45-degree field of view: 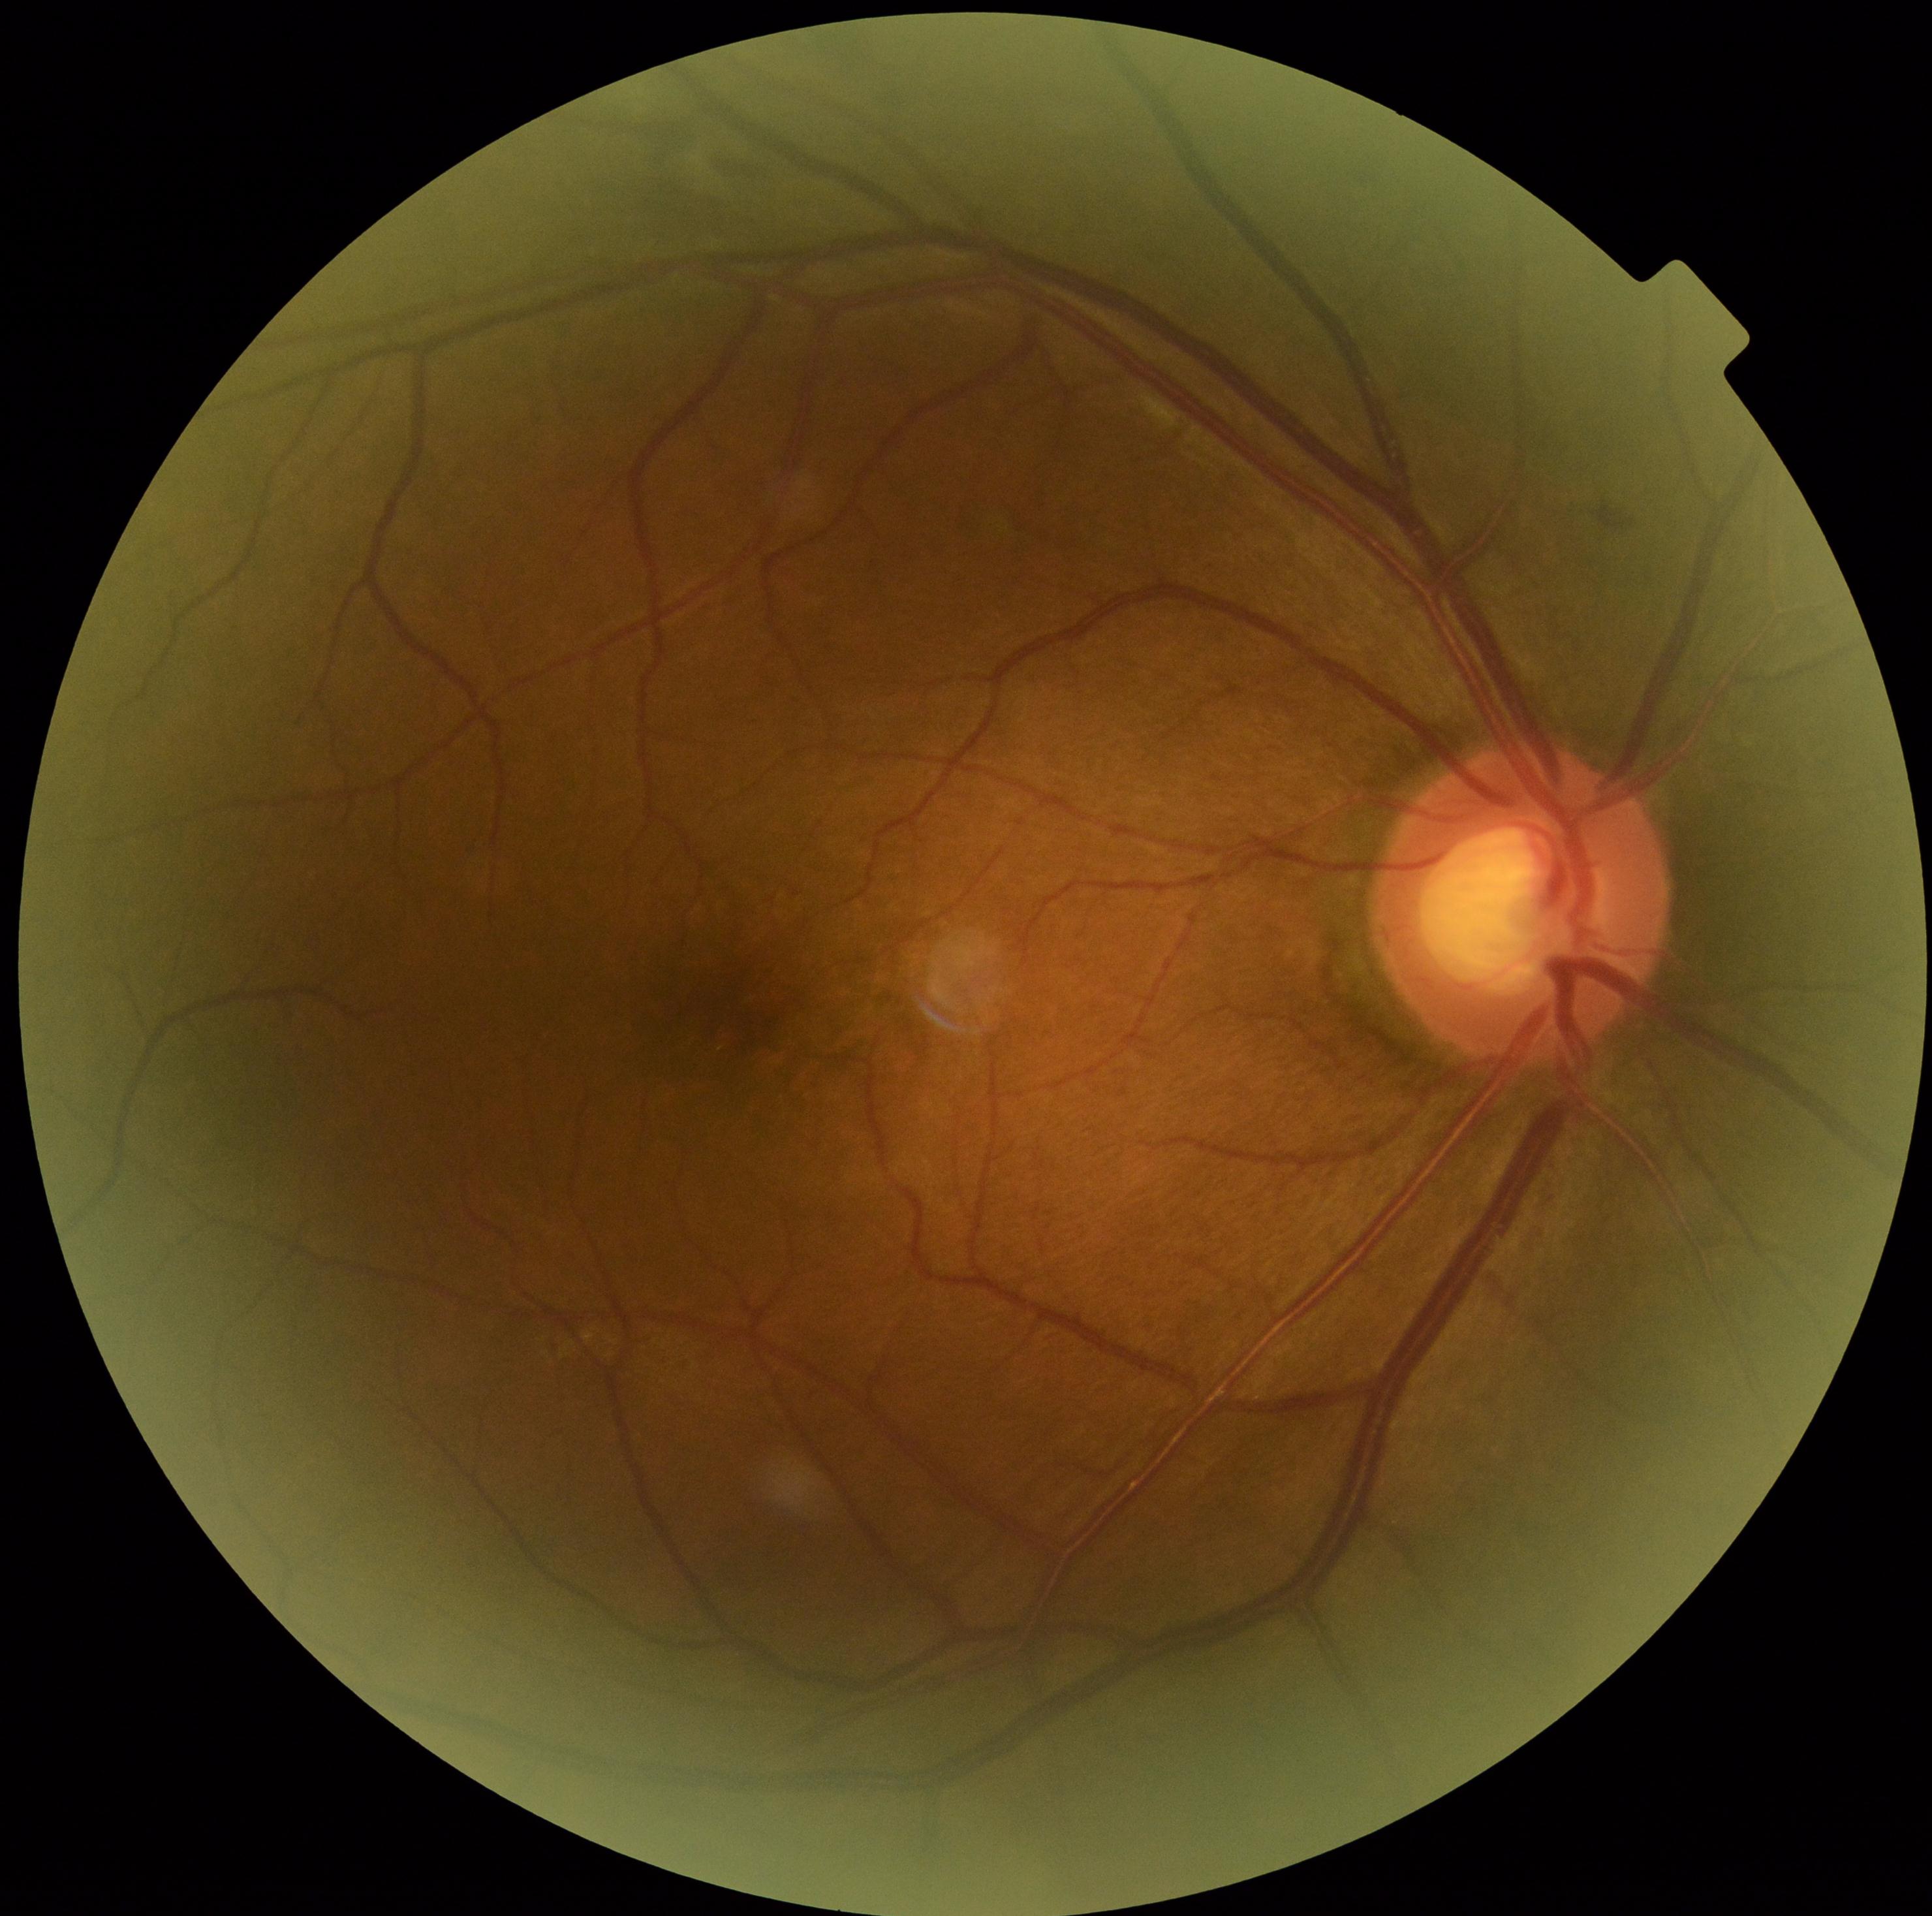

The retinopathy is classified as non-proliferative diabetic retinopathy. DR grade is 2.